Graded on the modified Davis scale; 848x848px; 45-degree field of view: 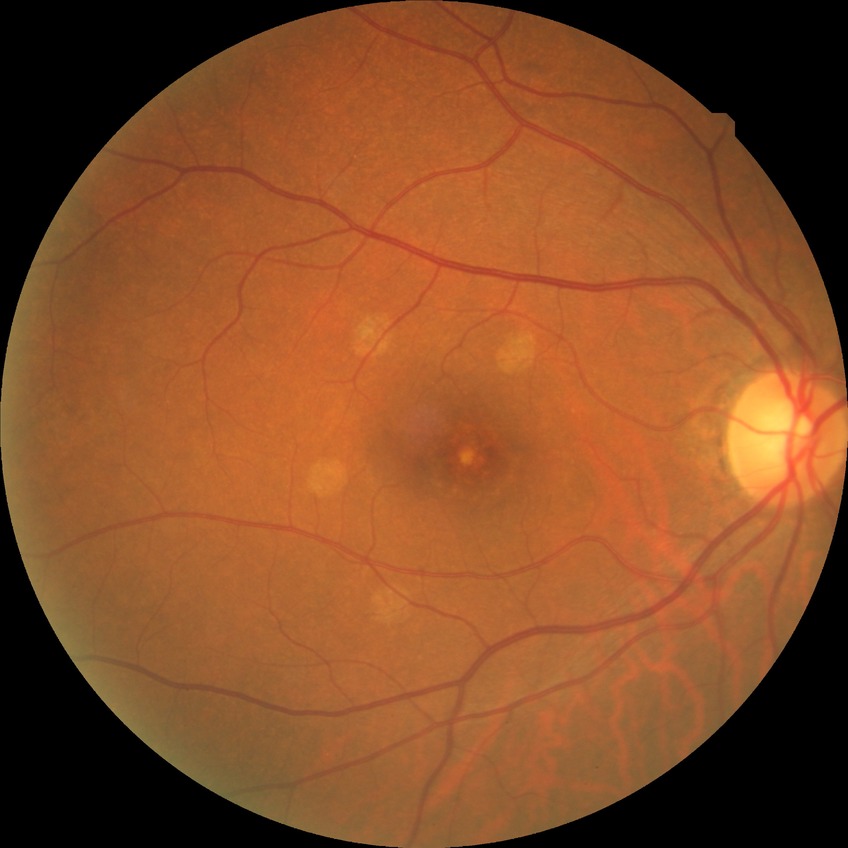

Modified Davis classification: no diabetic retinopathy.